45° FOV · 2212 x 1659 pixels · color fundus photograph:
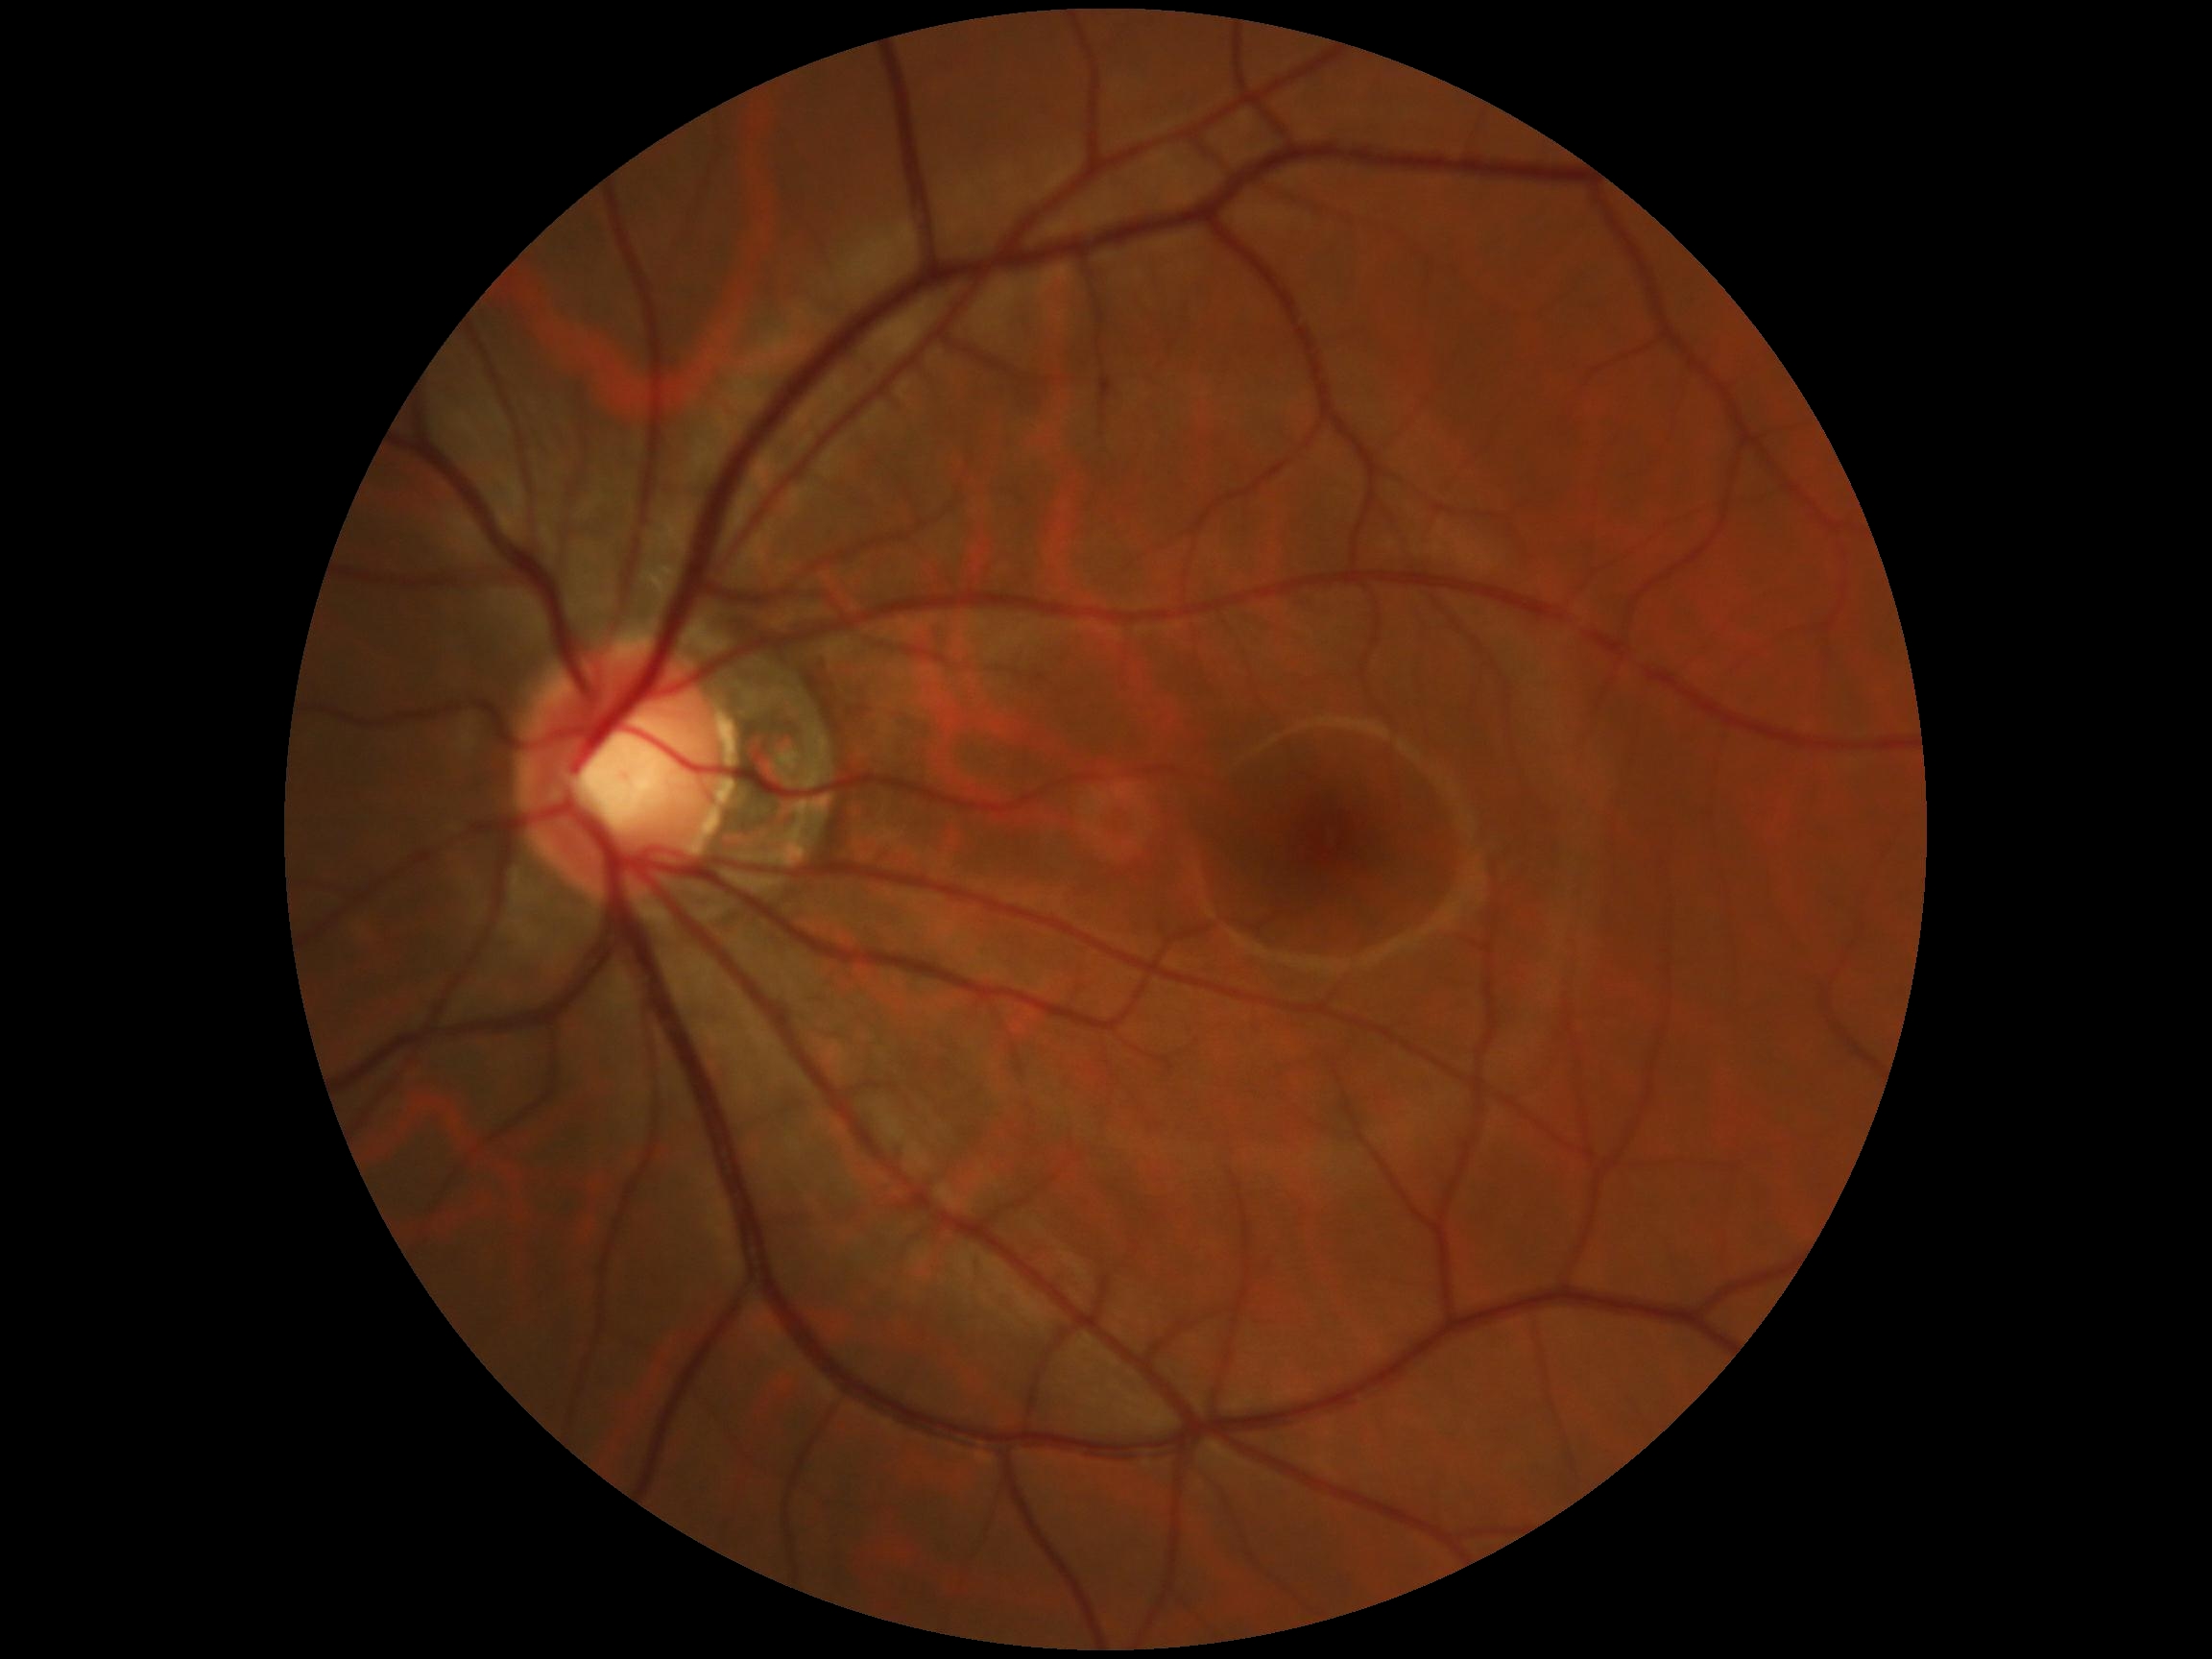 Retinopathy grade is 0.